640 by 480 pixels; pediatric retinal photograph (wide-field) — 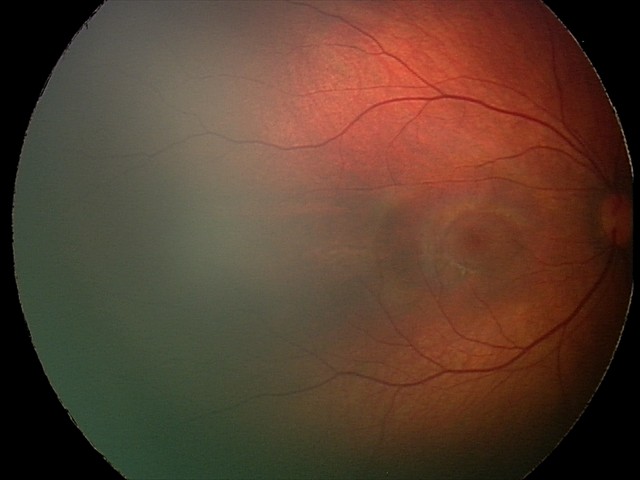

Series diagnosed as retinal hemorrhages.